45° field of view.
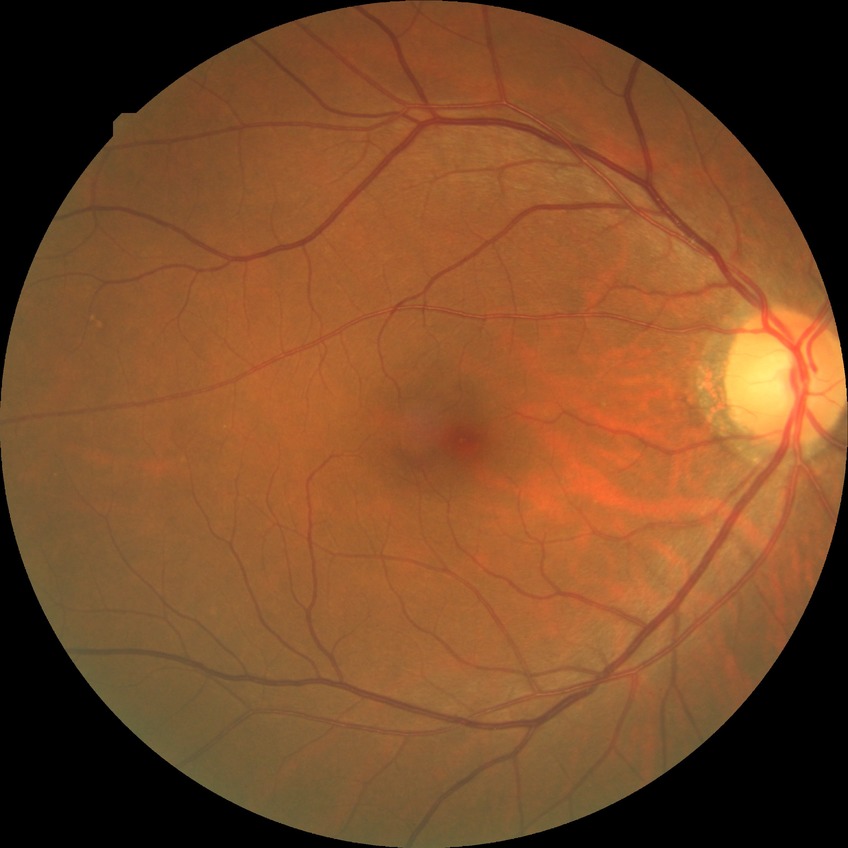
Retinopathy grade: no diabetic retinopathy.